Pediatric wide-field fundus photograph. Captured with the Phoenix ICON (100° field of view). 1240 by 1240 pixels: 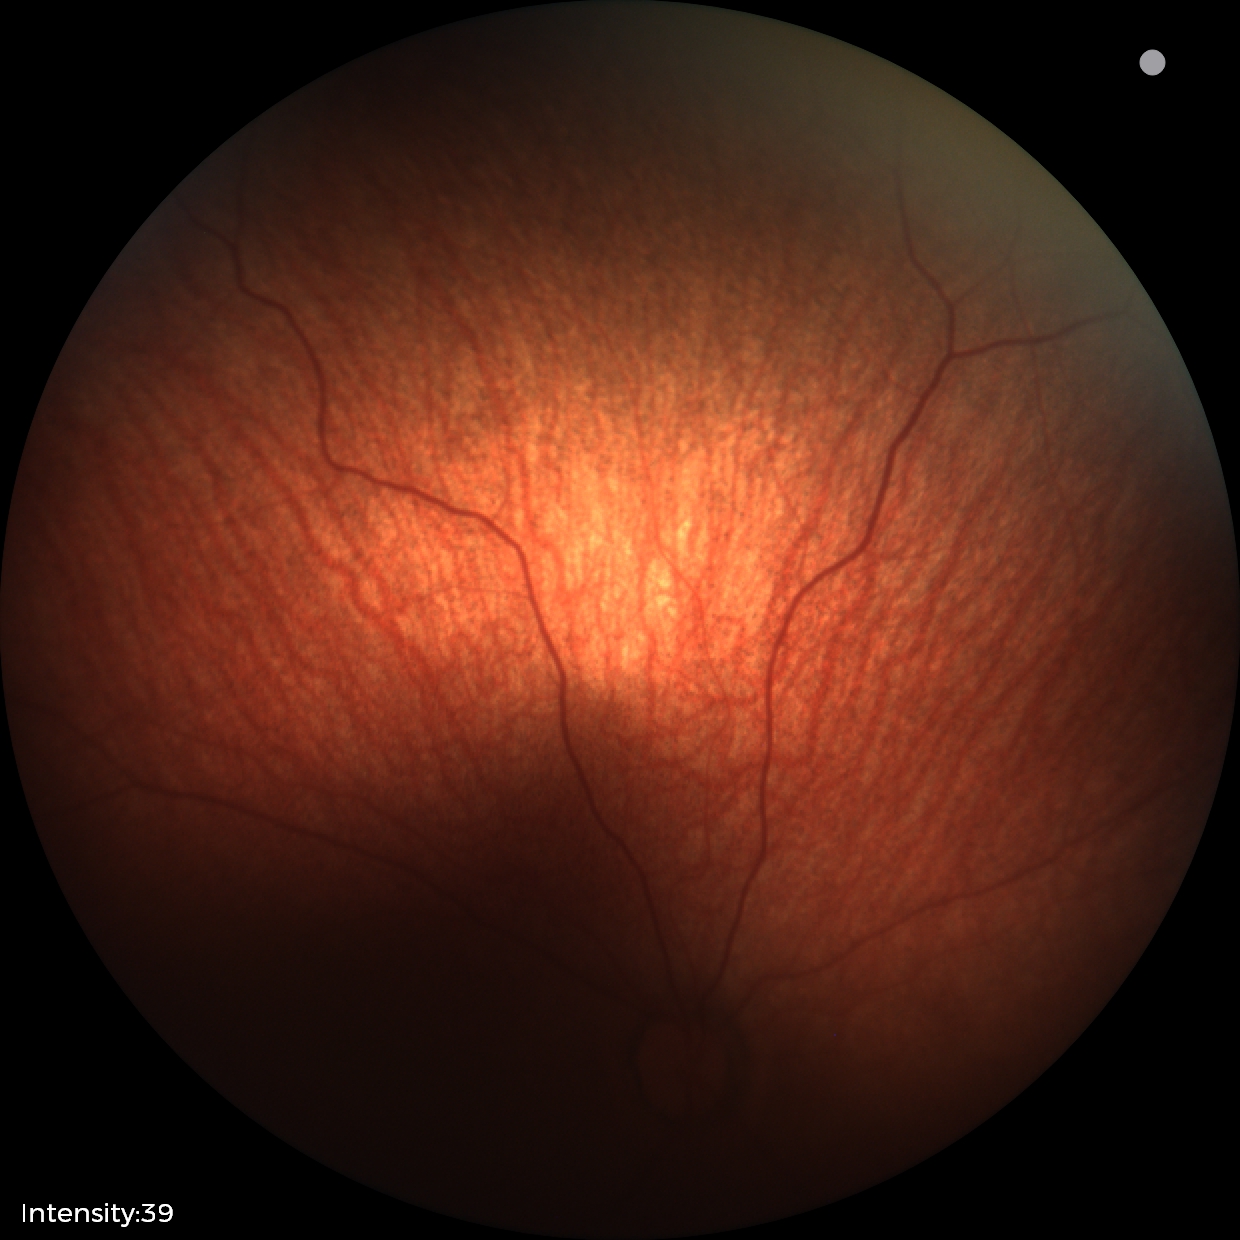
Impression: normal fundus examination.